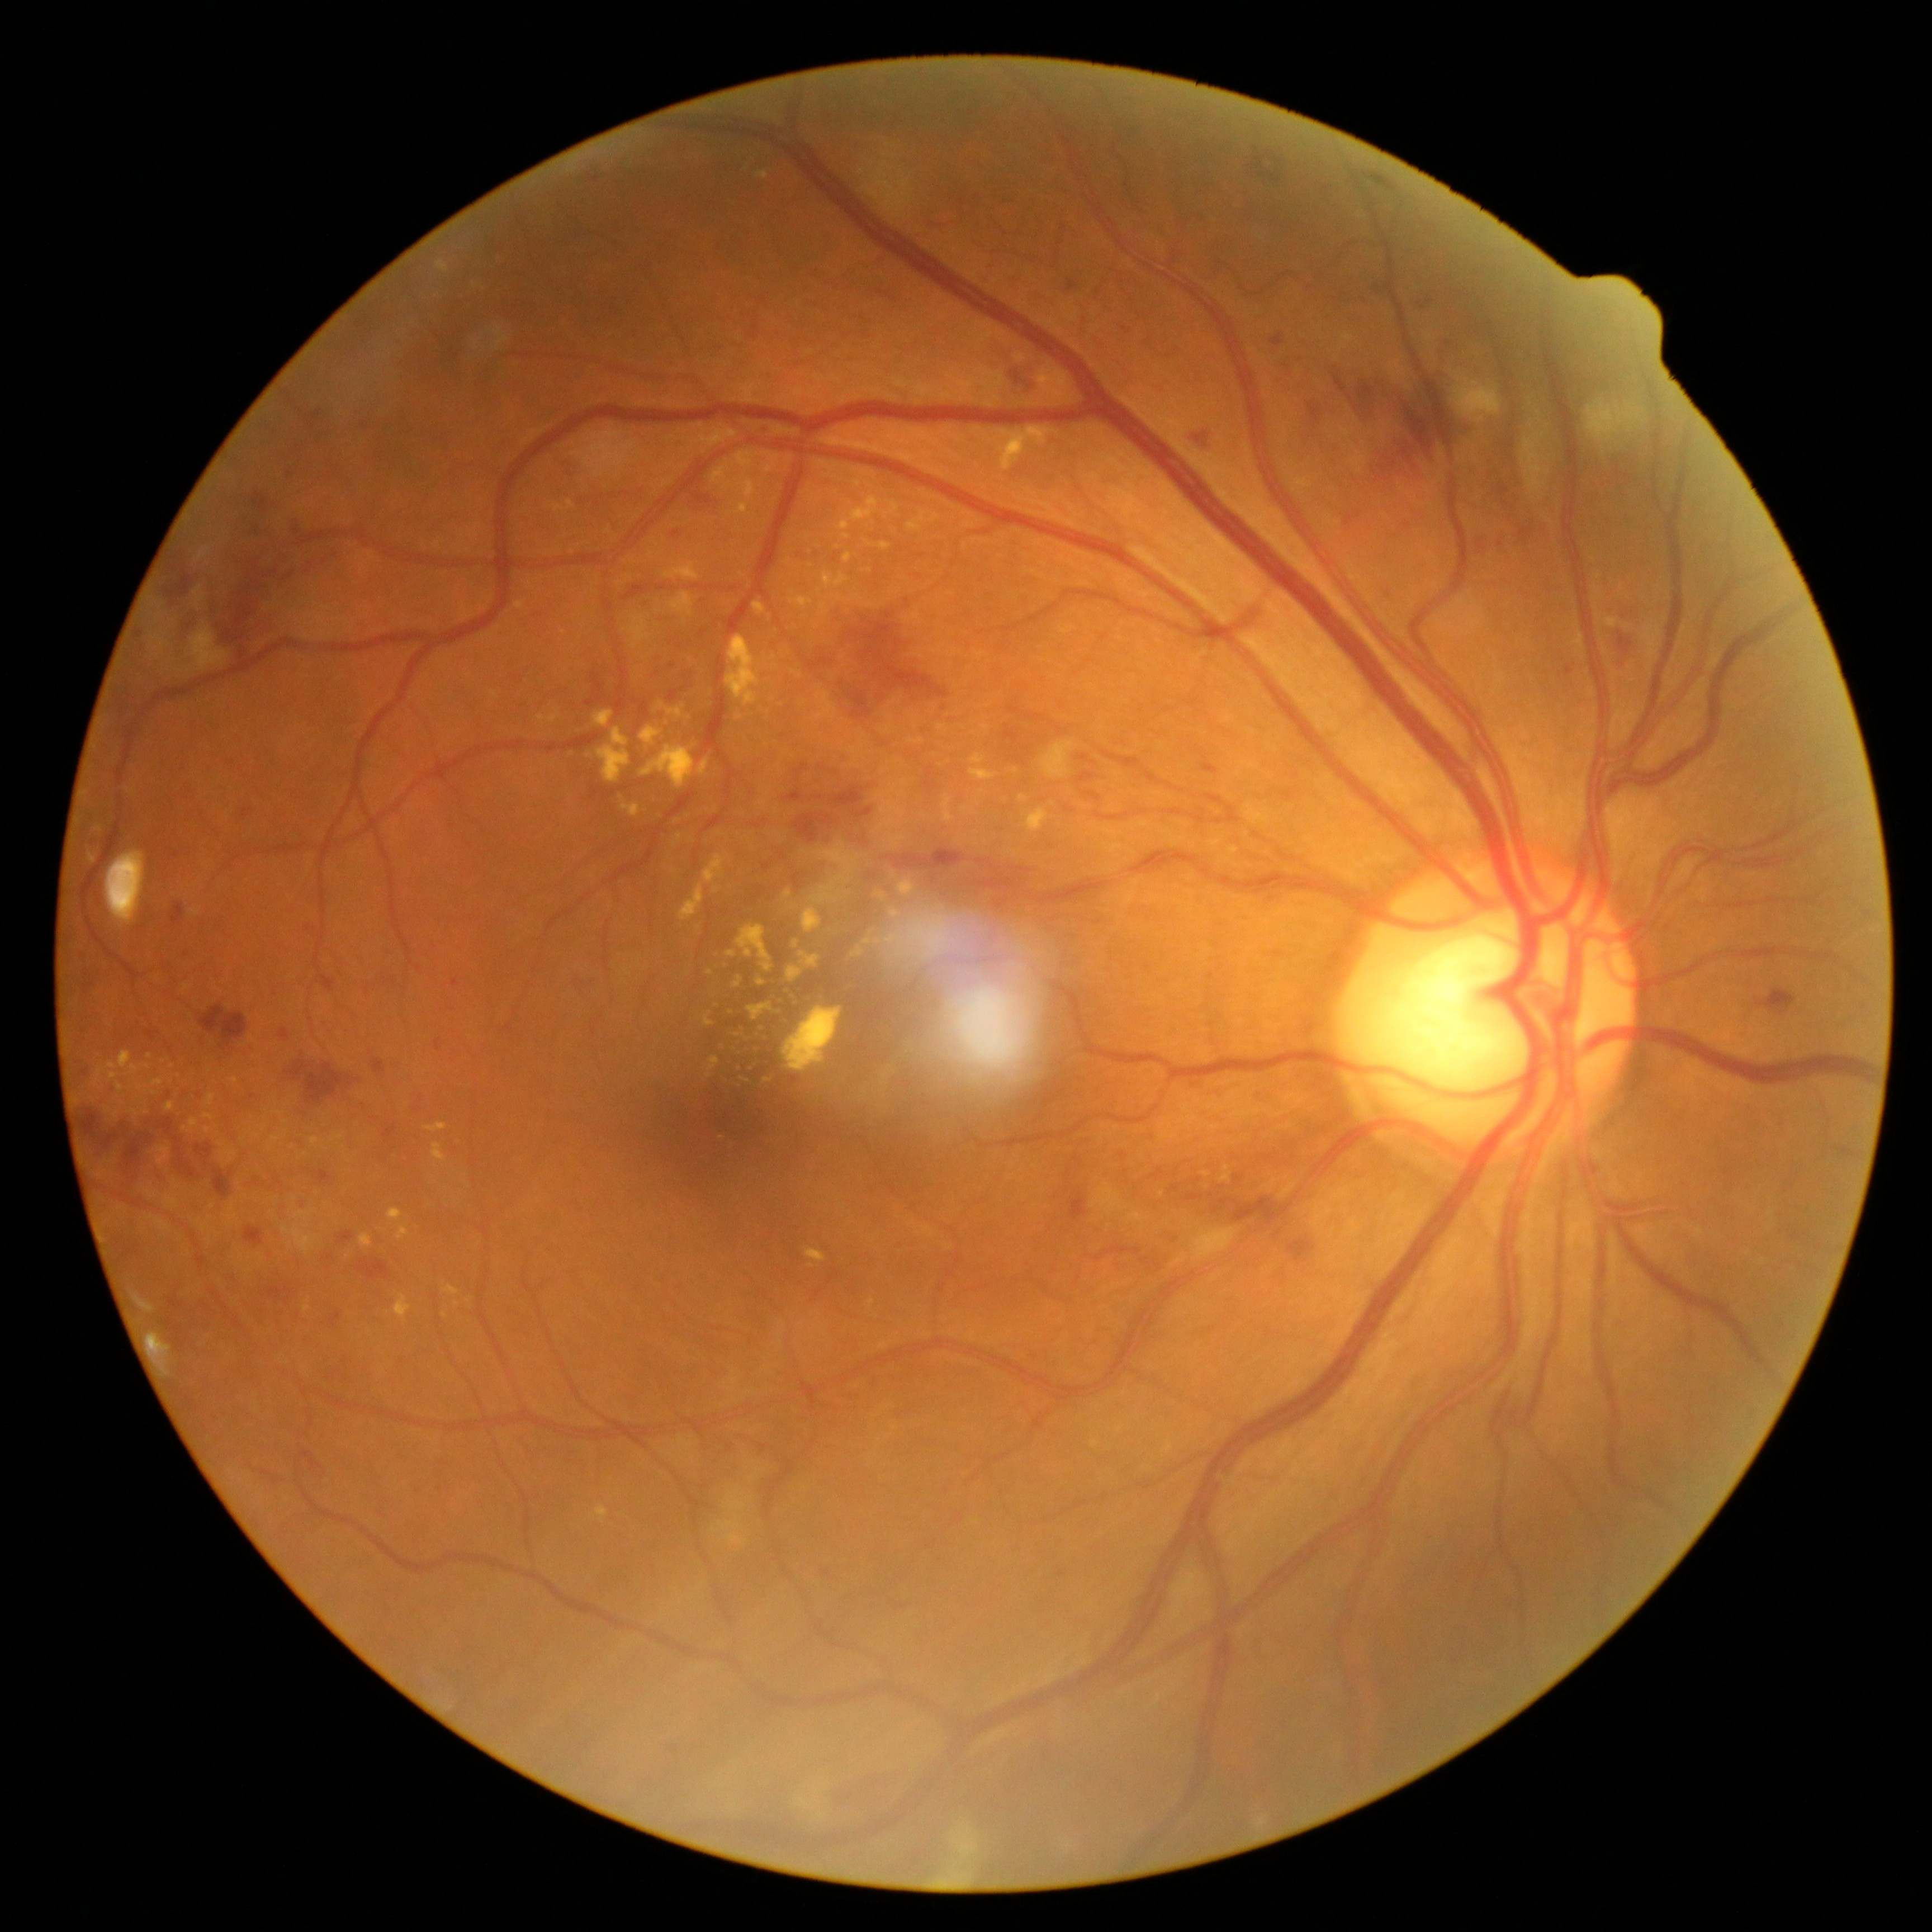 Diabetic retinopathy (DR) is severe NPDR (grade 3)
Representative lesions:
soft exudates (SEs): (952,1824,979,1860) | (1041,743,1077,779) | (858,153,920,220) | (1130,1214,1144,1224) | (1094,1186,1126,1216) | (1191,1228,1237,1261) | (1521,423,1550,500) | (813,1815,823,1821) | (1586,400,1645,442) | (795,1787,823,1811) | (187,628,226,671) | (194,586,205,603) | (935,1874,971,1886) | (713,1488,752,1547) | (1453,373,1503,424) | (198,547,212,561)
hemorrhages (HEs) (subset): (1169,1236,1175,1246) | (305,1063,355,1104) | (1310,403,1322,423) | (1273,335,1284,346) | (1290,1243,1311,1259) | (1007,376,1030,392) | (853,809,873,820) | (793,815,837,844) | (1234,1175,1243,1183) | (320,977,337,993) | (74,1056,102,1083) | (1757,989,1797,1015) | (332,1313,342,1329) | (787,791,802,802) | (1355,382,1375,412) | (1401,378,1453,459) | (172,488,302,657) | (894,849,968,884) | (286,1062,314,1081)
Small HEs approximately at [1198,1181]
microaneurysms (MAs) (subset): (435,1041,442,1053) | (1520,527,1532,539) | (314,1171,333,1183) | (1201,764,1219,775) | (297,1201,306,1207) | (1068,282,1076,291) | (288,471,293,479) | (451,980,459,988) | (243,809,254,819) | (311,412,320,421)
Small MAs approximately at [1422,307] | [794,1080]
hard exudates (EXs) (subset): (806,1251,826,1263) | (668,593,693,617) | (802,842,861,934) | (311,1139,323,1148) | (1604,619,1618,628) | (515,603,525,610) | (736,924,773,973) | (389,1209,403,1221) | (594,711,613,728) | (166,1103,175,1112) | (442,1286,459,1295)
Small EXs approximately at [1207,1175] | [981,792] | [1052,805] | [759,1033] | [847,894] | [775,667] | [771,1048]